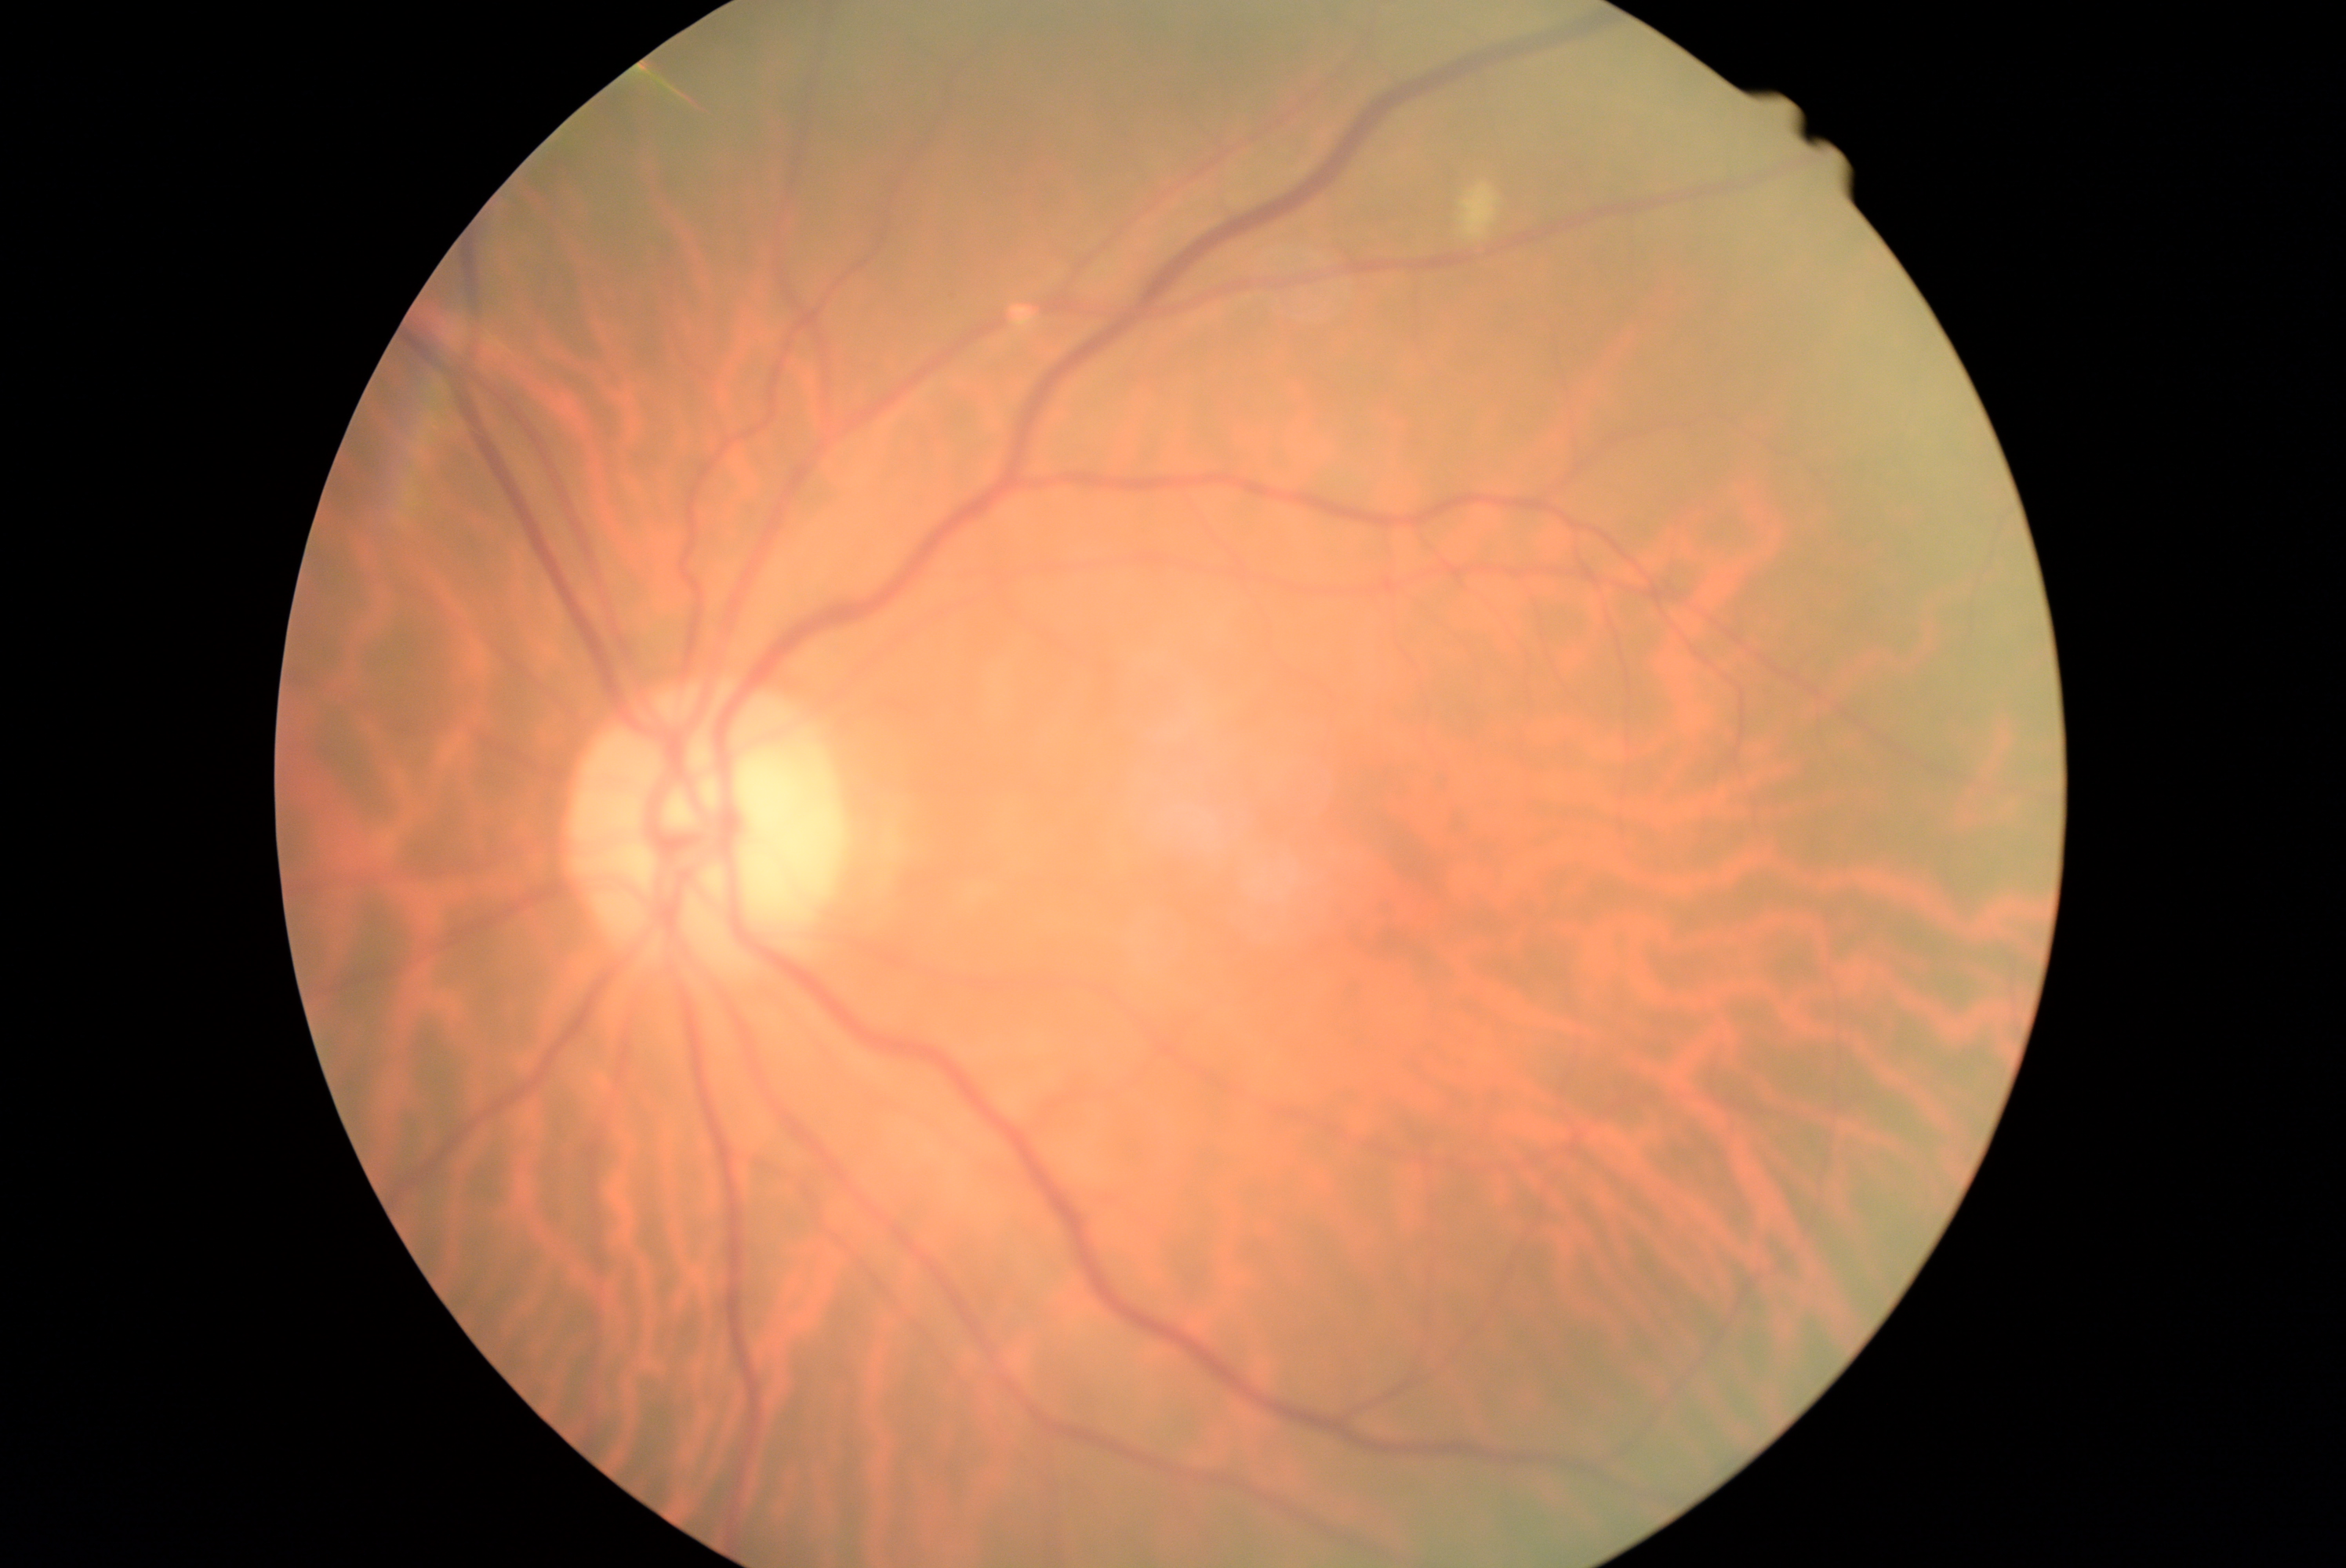

Annotations:
• diabetic retinopathy grade: 2 (moderate NPDR)
• DR class: non-proliferative diabetic retinopathy